Phoenix ICON wide-field infant fundus image
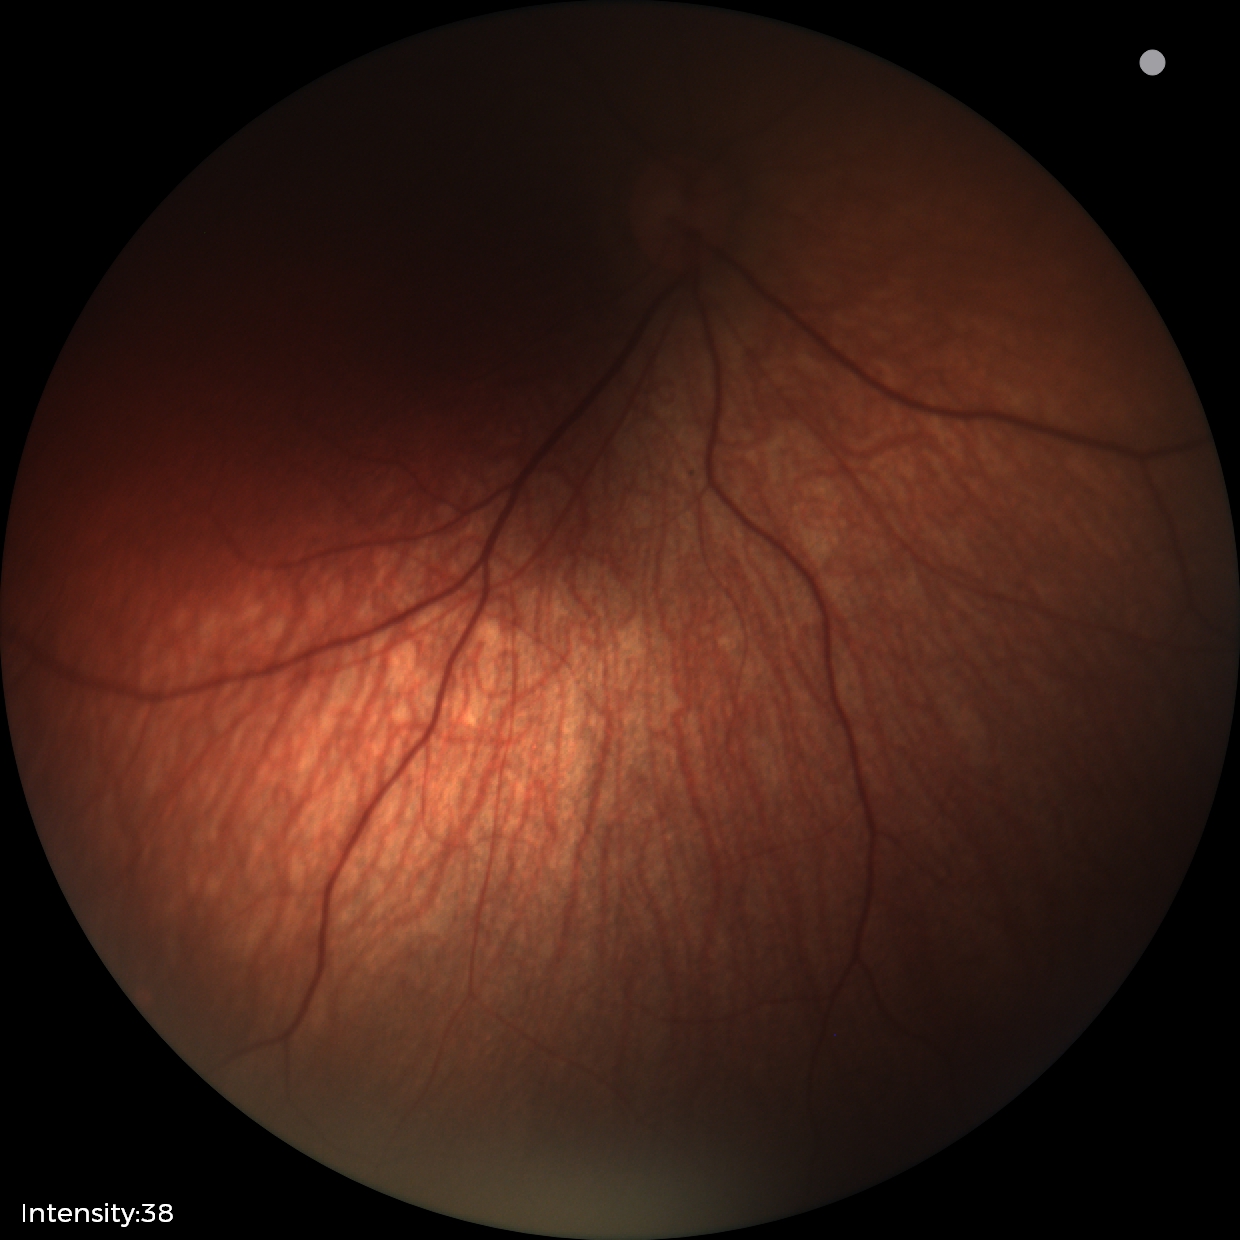

Normal screening examination.